Modified Davis classification.
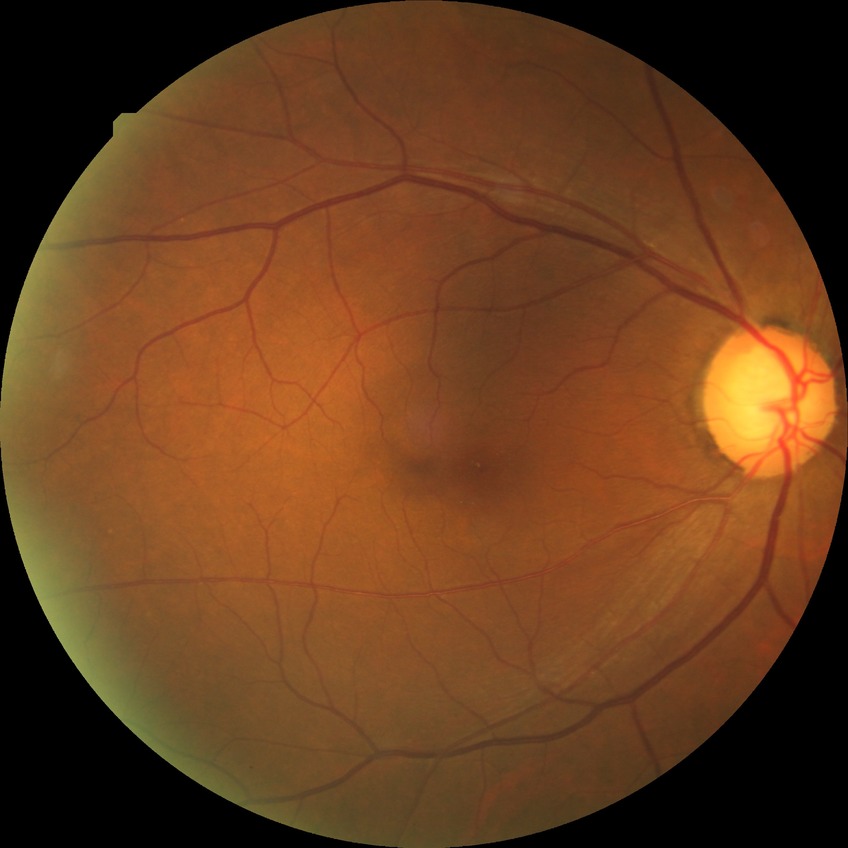
- diabetic retinopathy (DR): NDR (no diabetic retinopathy)